2352 x 1568 pixels; 45° FOV
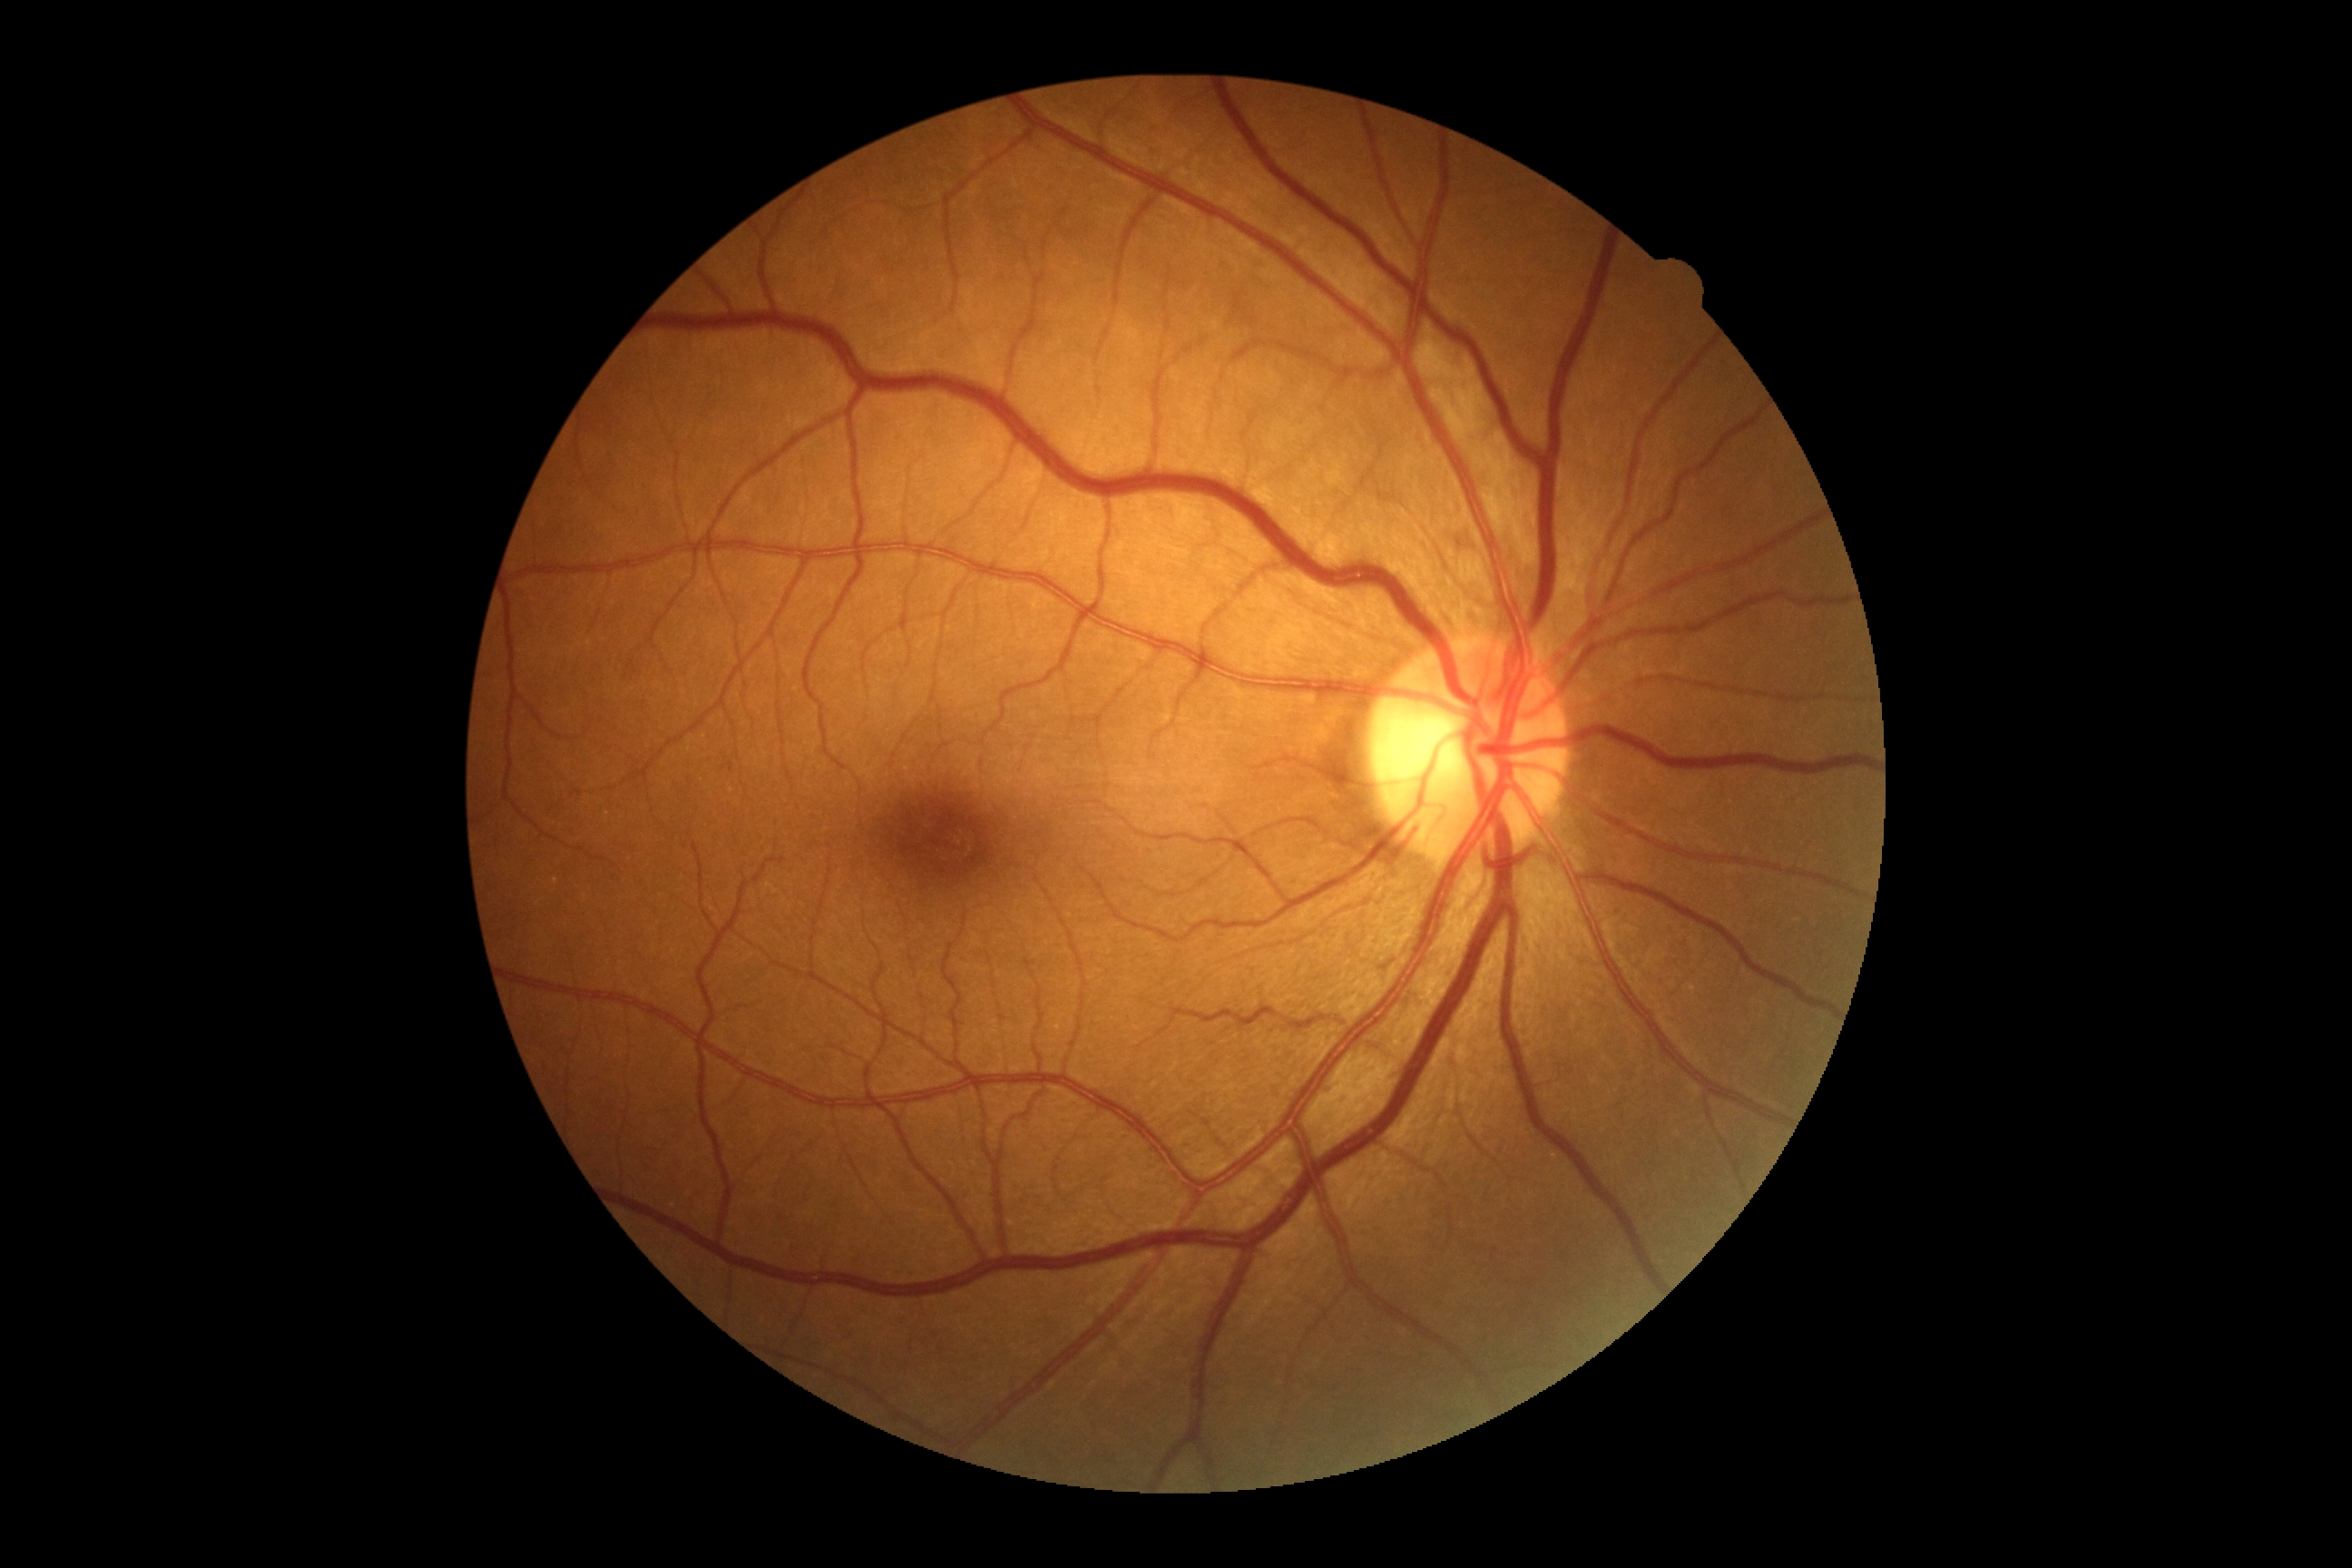 DR impression = no DR findings; DR severity = grade 0 (no apparent retinopathy).